45° FOV · retinal fundus photograph.
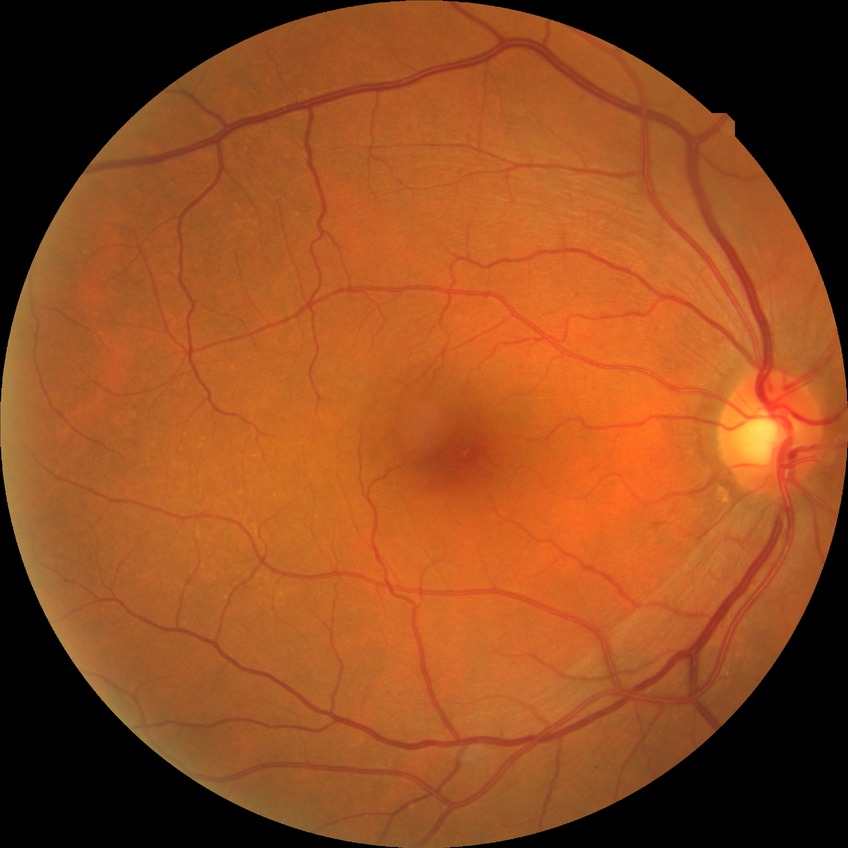

Davis stage = NDR